Retinal fundus photograph · 2212 by 1672 pixels · 45-degree field of view:
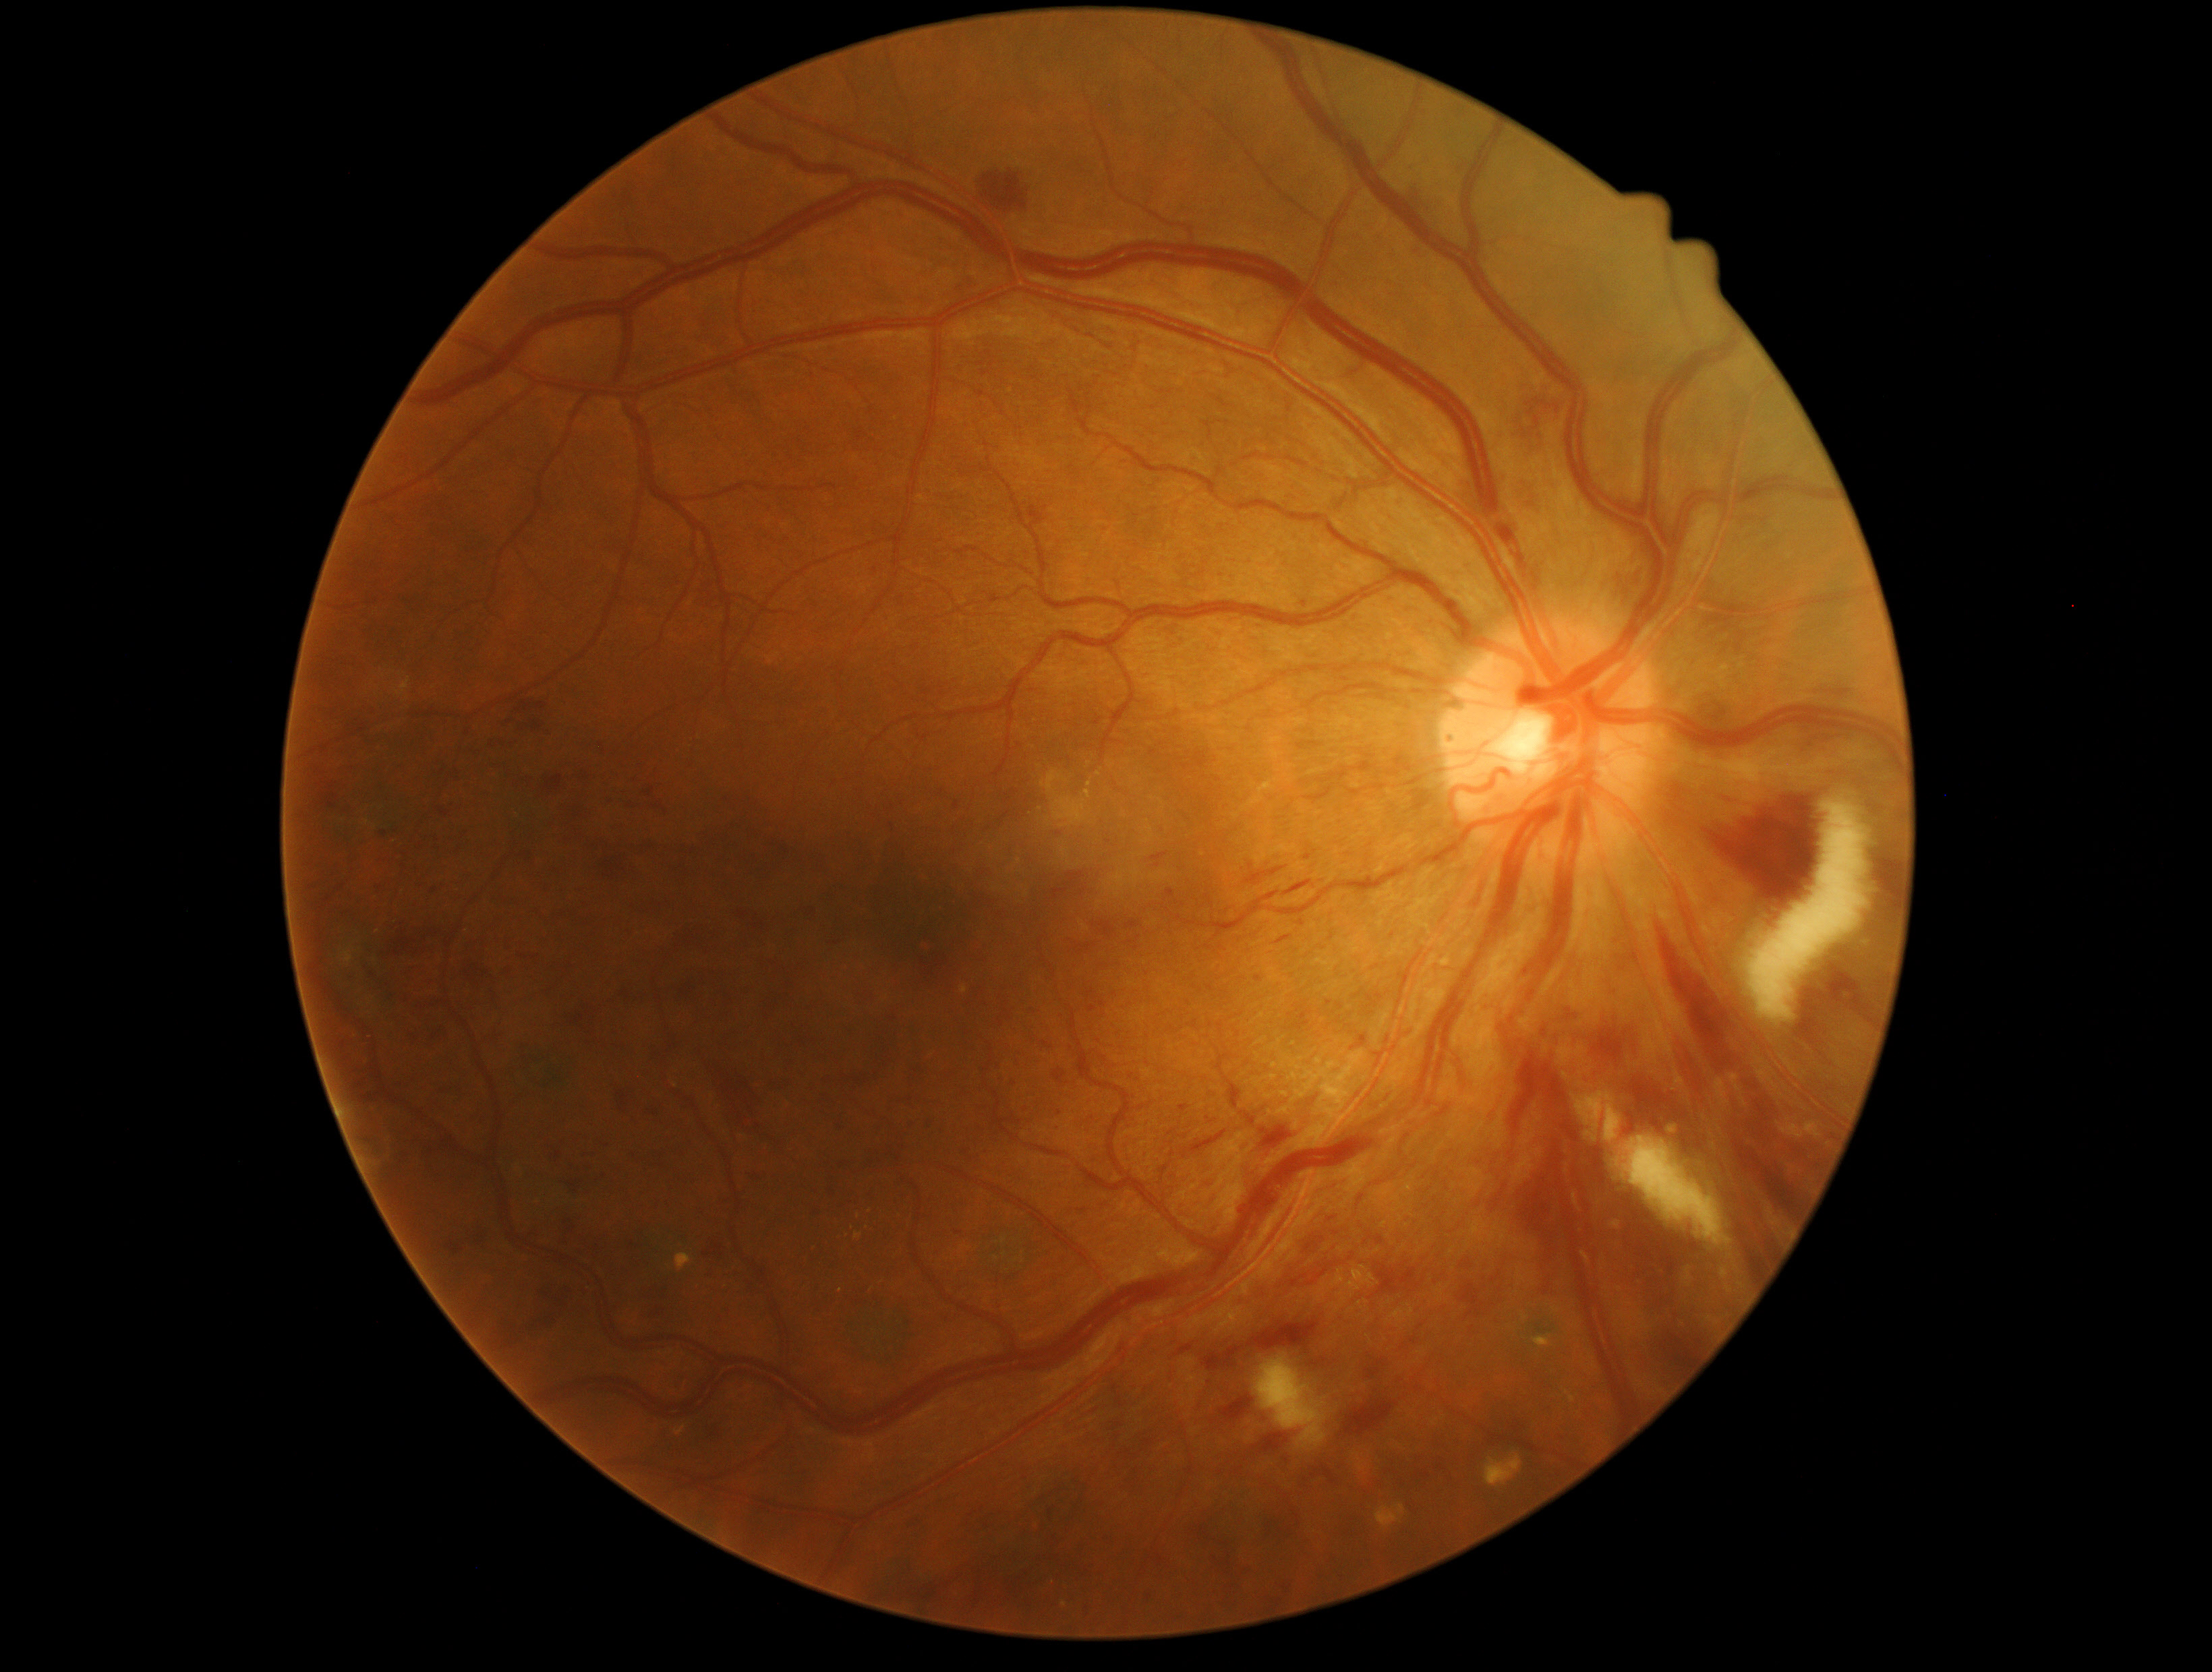

DR stage is 3/4 — more than 20 intraretinal hemorrhages in each of 4 quadrants, definite venous beading in 2 or more quadrants, or prominent intraretinal microvascular abnormalities in 1 or more quadrants, with no signs of proliferative retinopathy.